Camera: Remidio smartphone fundus camera: 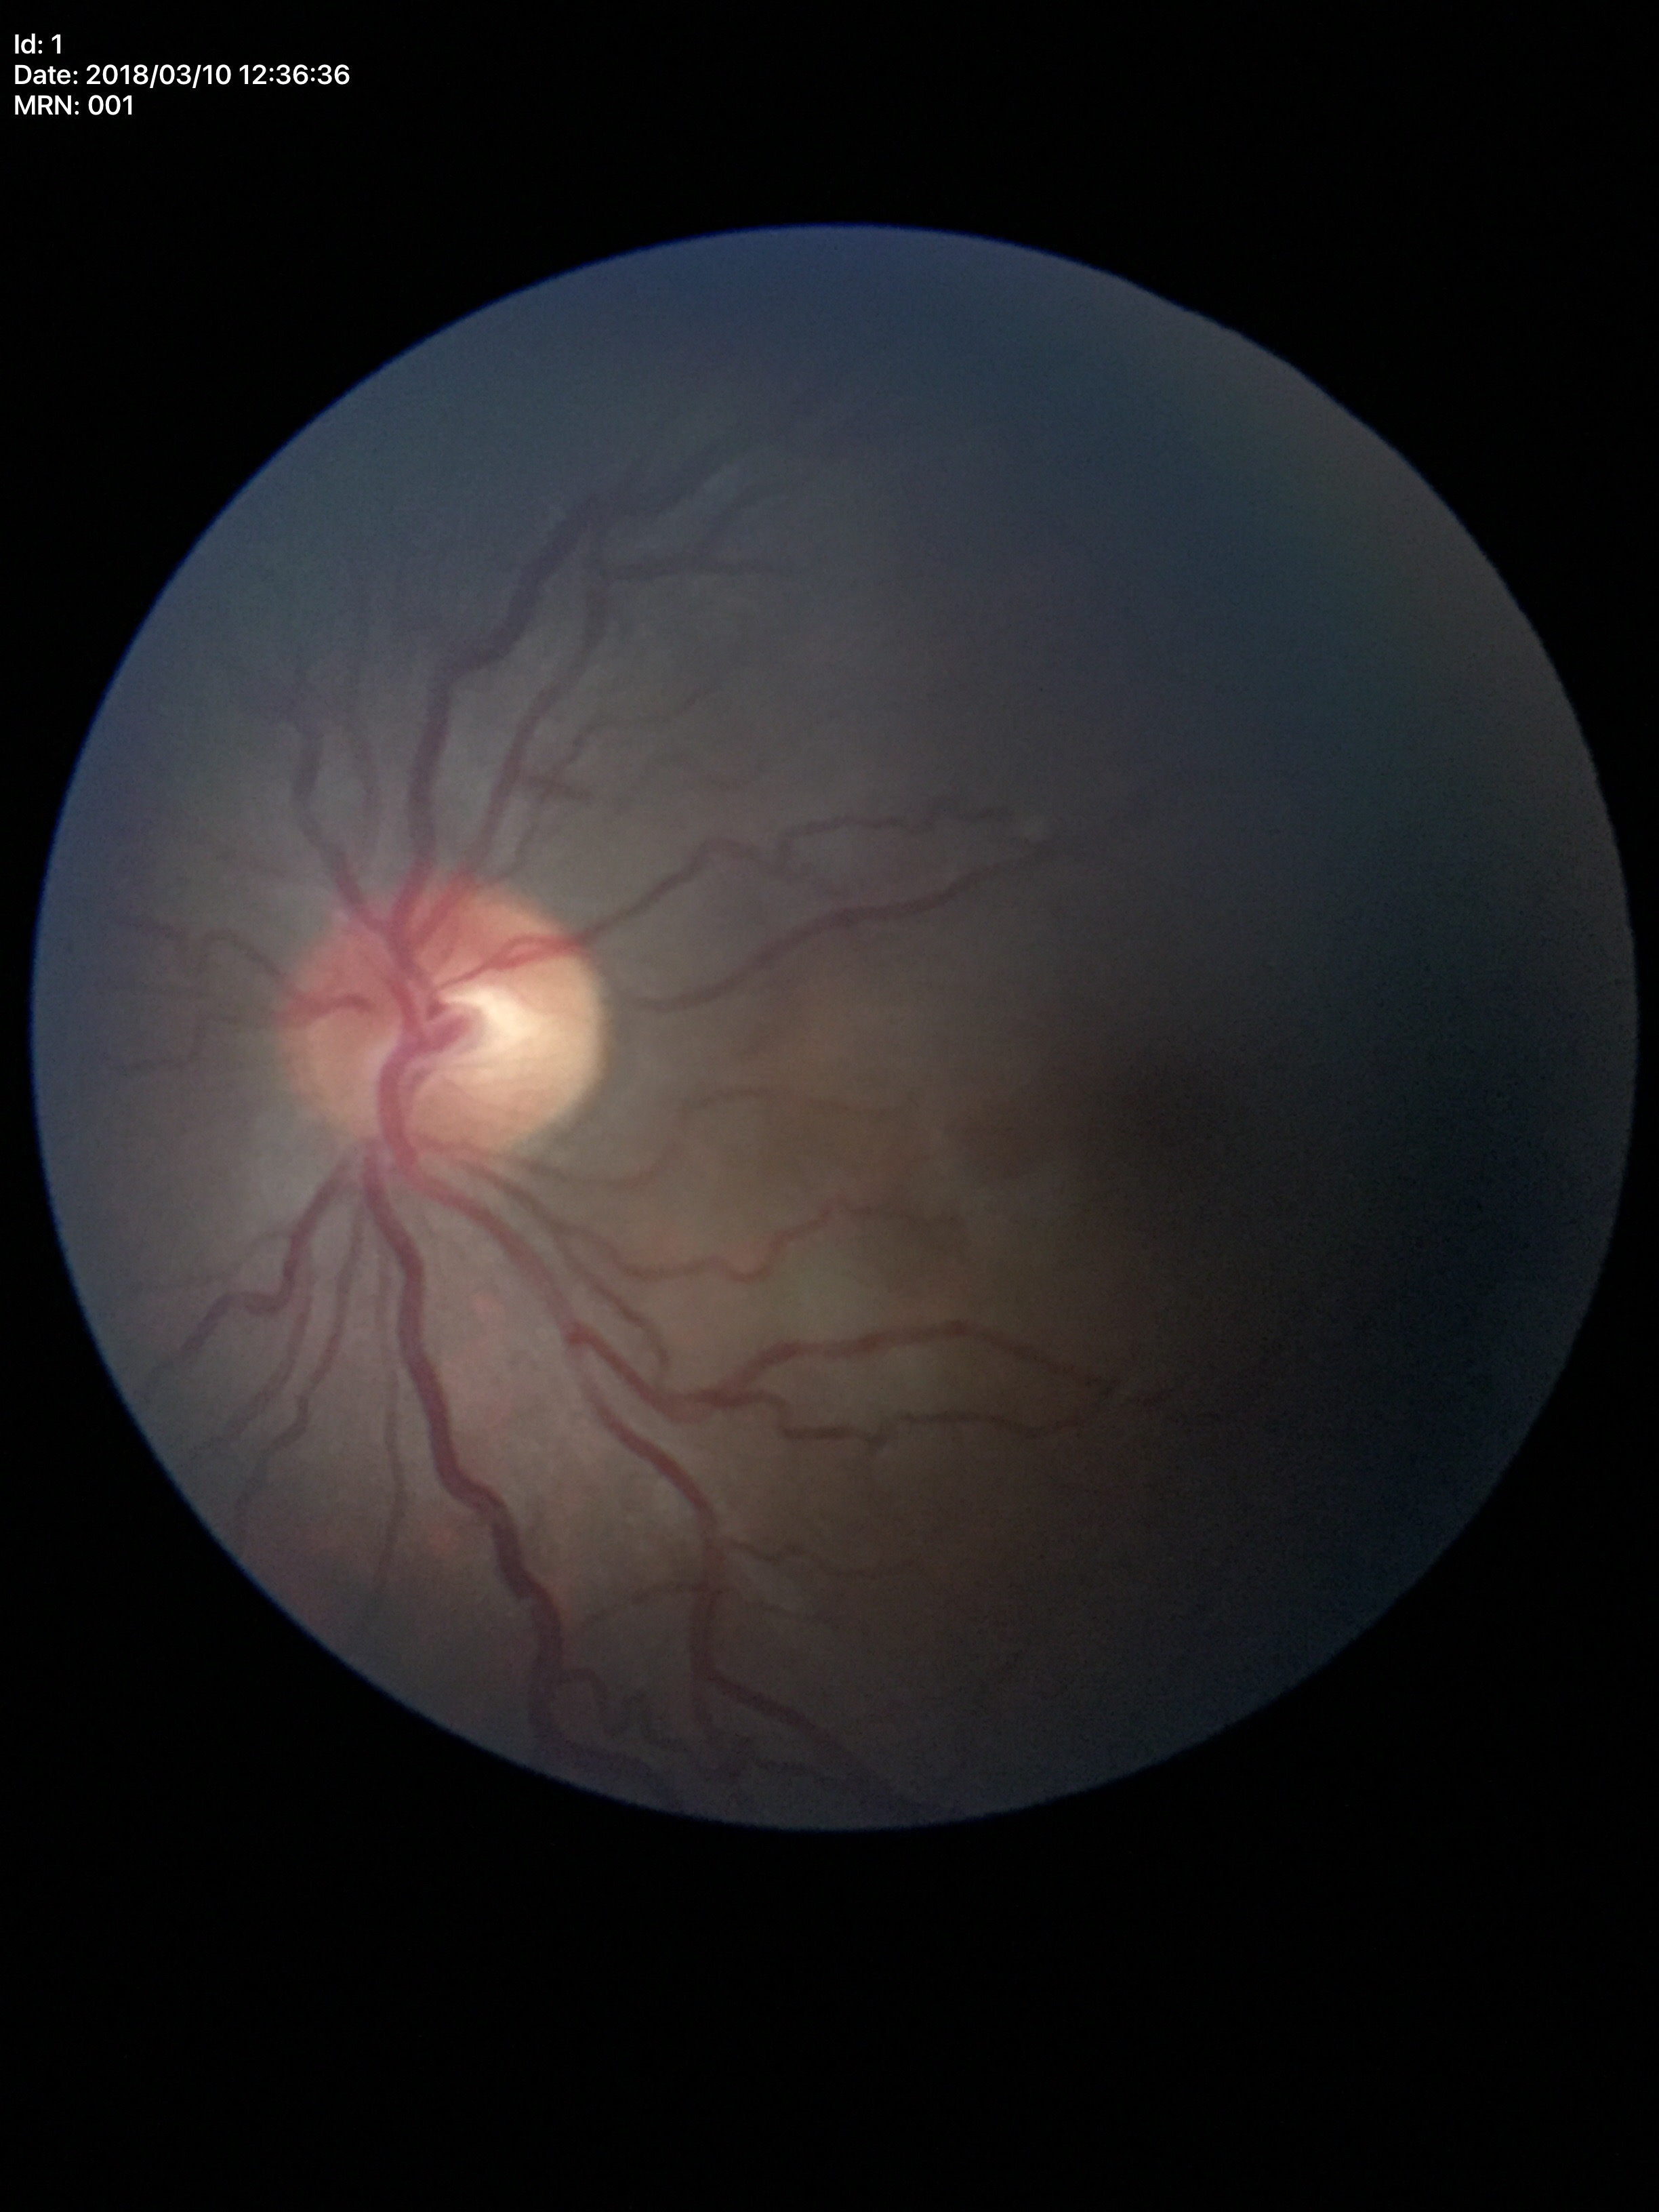

  glaucoma_decision: negative (5/5 ophthalmologists in agreement)
  vcdr: 0.47
  hcdr: 0.53